200° field of view. 1924x1556. Ultra-widefield fundus mosaic.
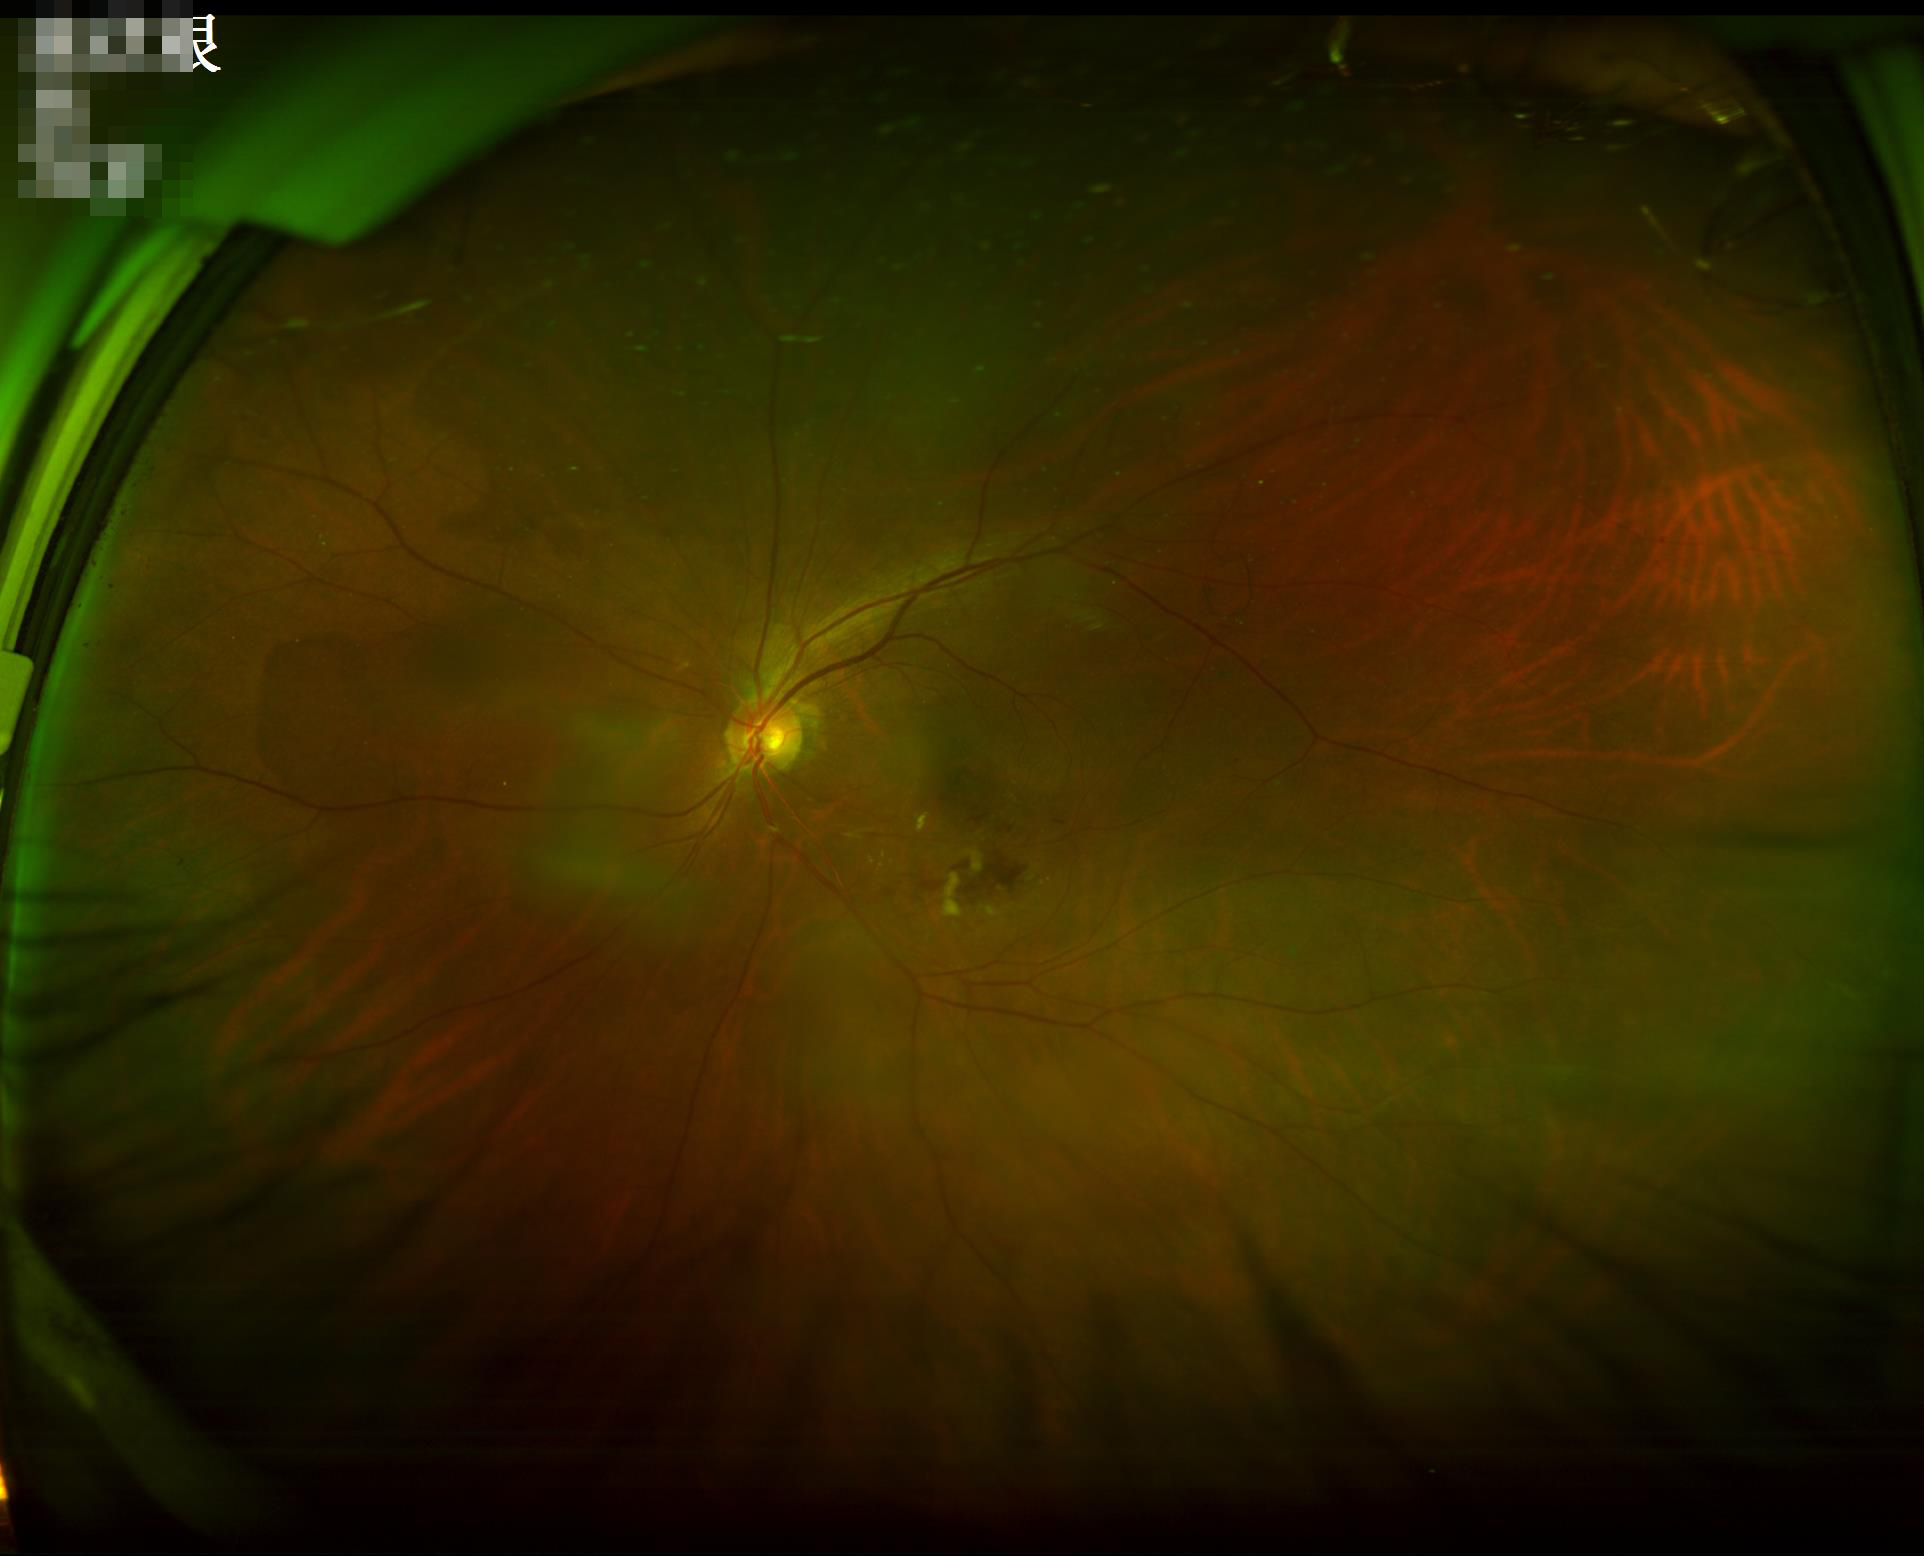
  overall_quality: acceptable
  contrast: adequate
  clarity: sharp
  illumination: suboptimal